Without pupil dilation, 848x848: 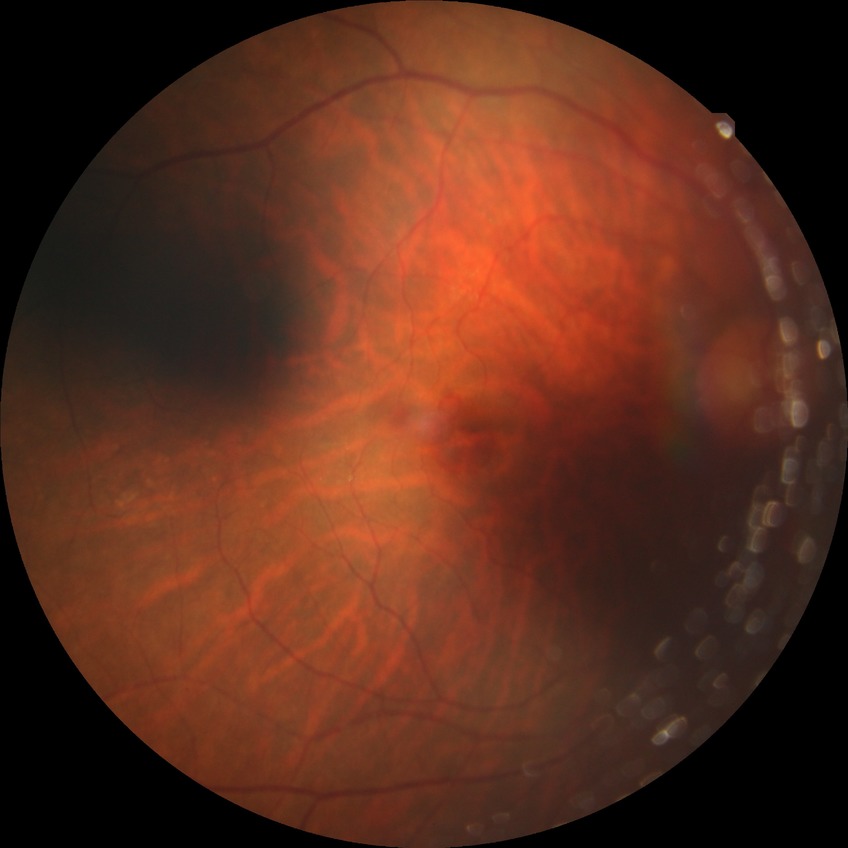
diabetic retinopathy (DR) = NDR (no diabetic retinopathy).